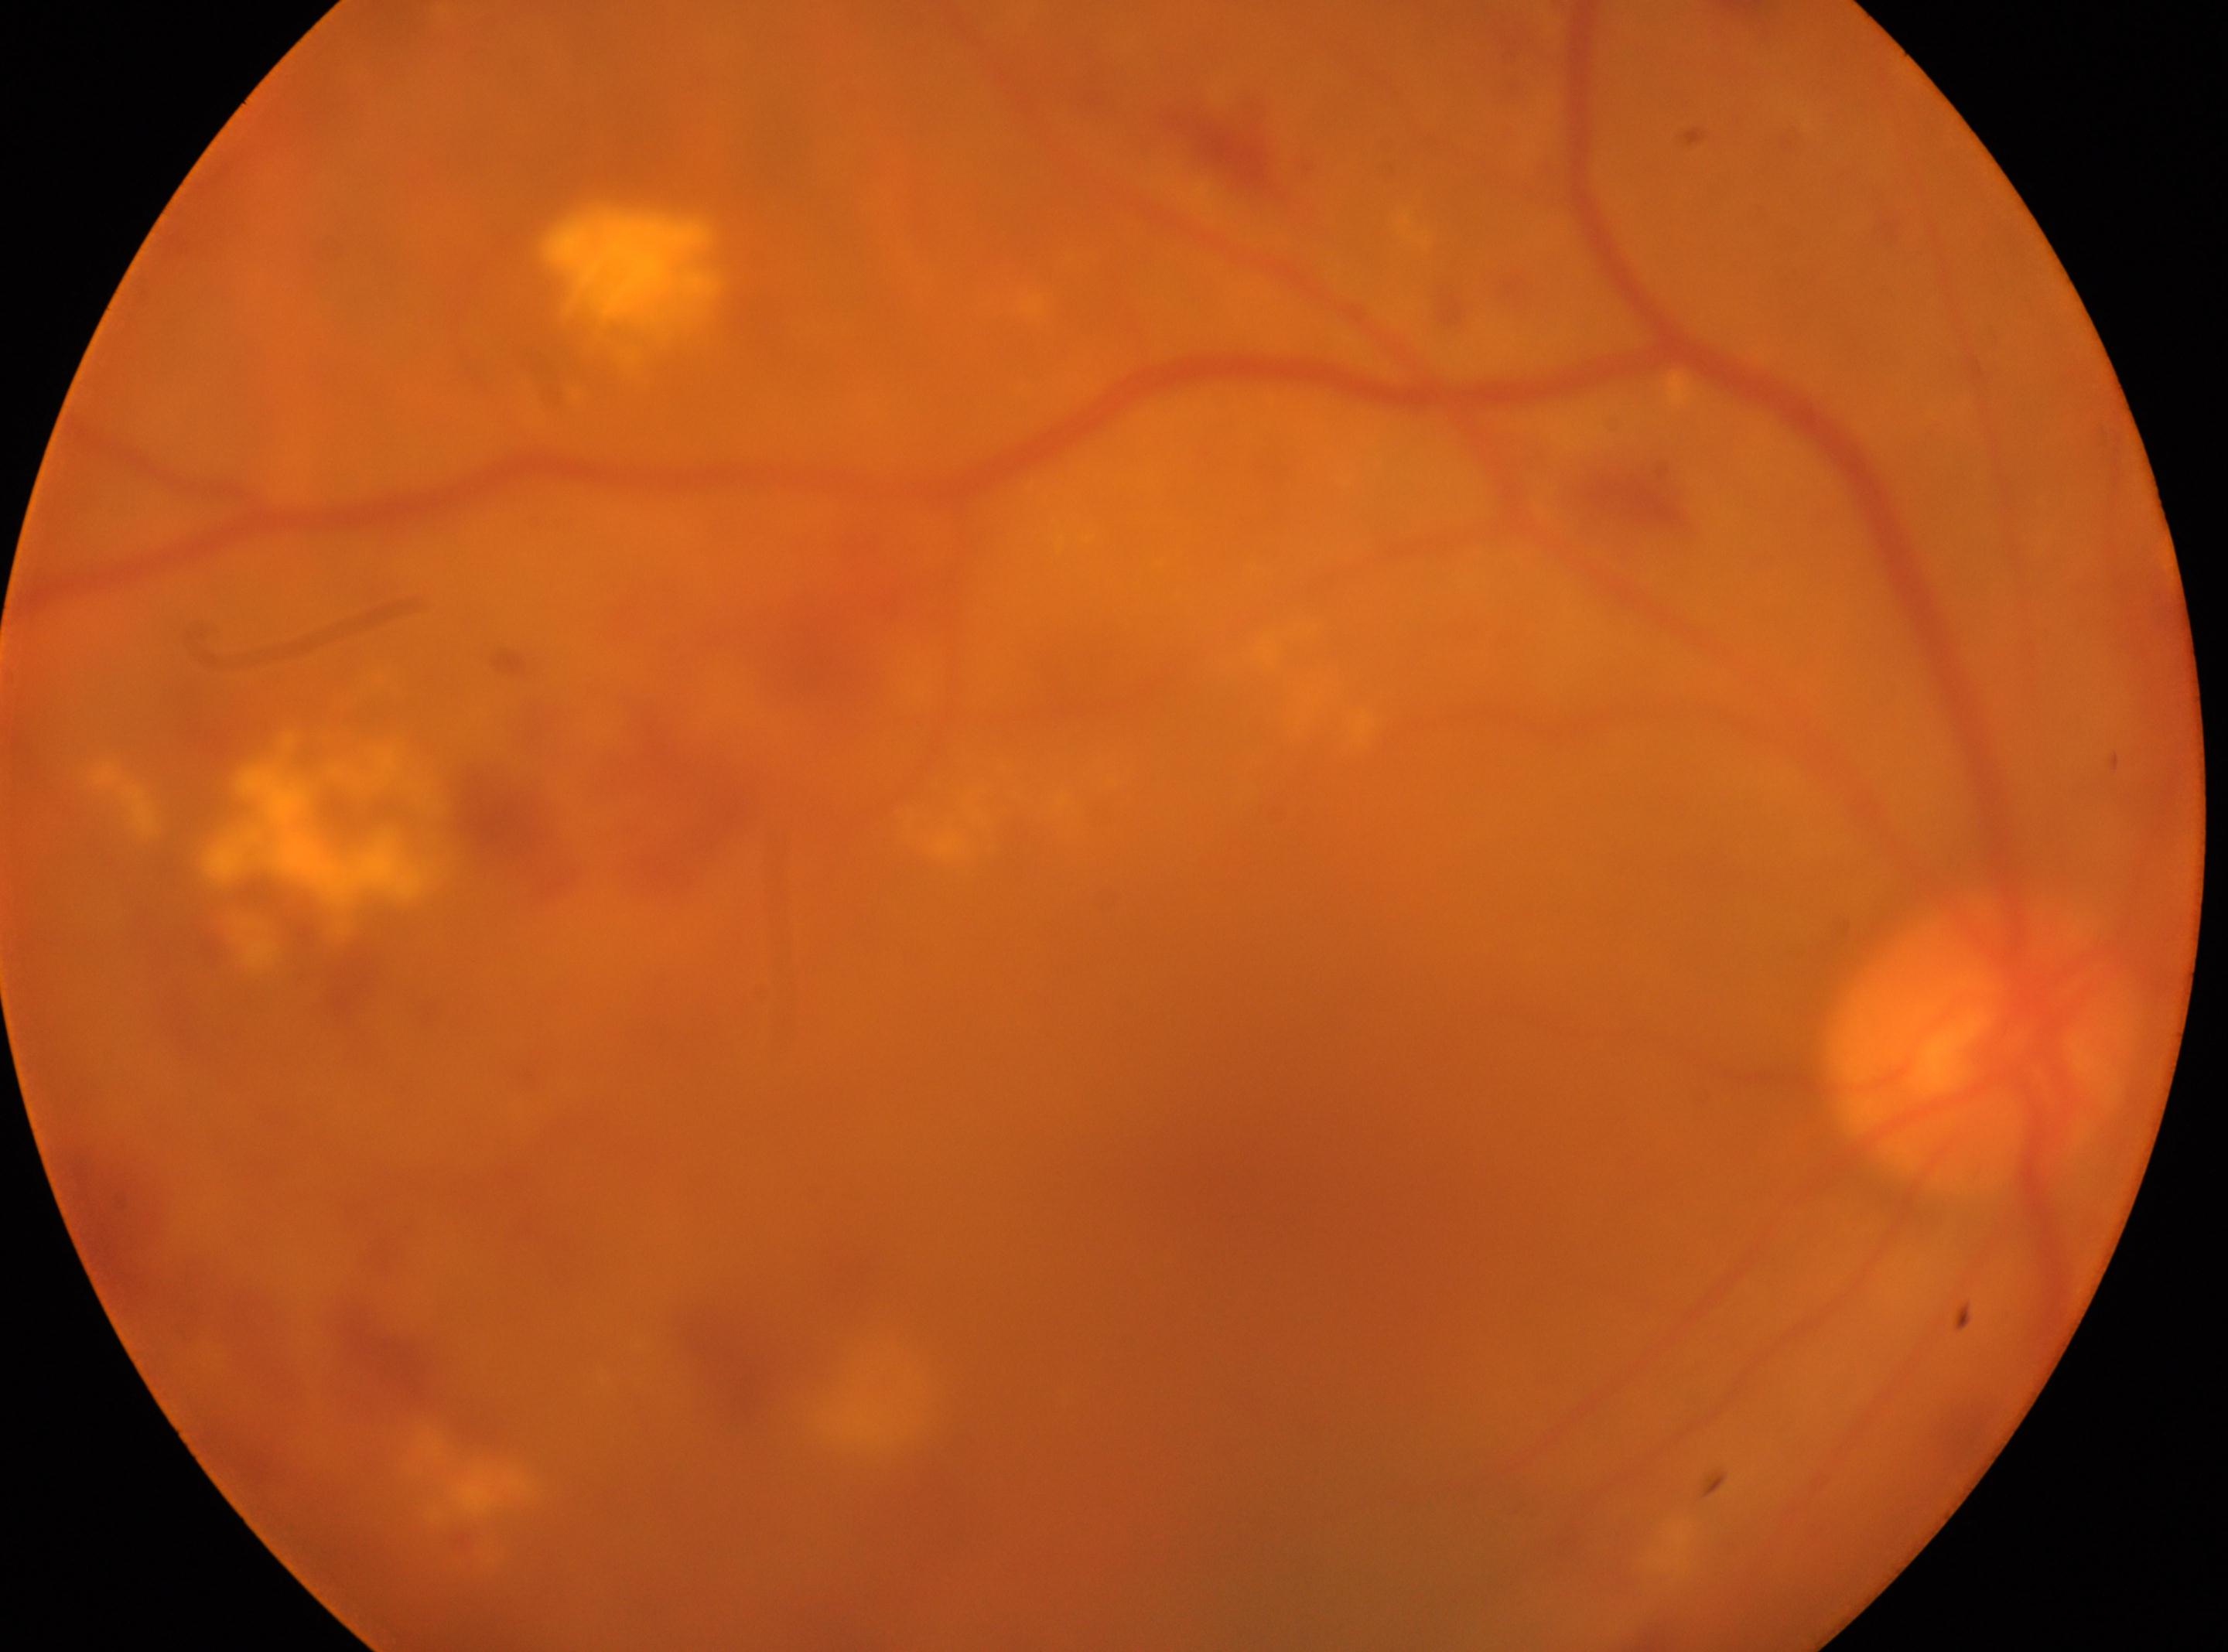
Macula center: 1230, 1165. Optic disc: 1978, 1042. DR stage: grade 2. Eye: oculus dexter.